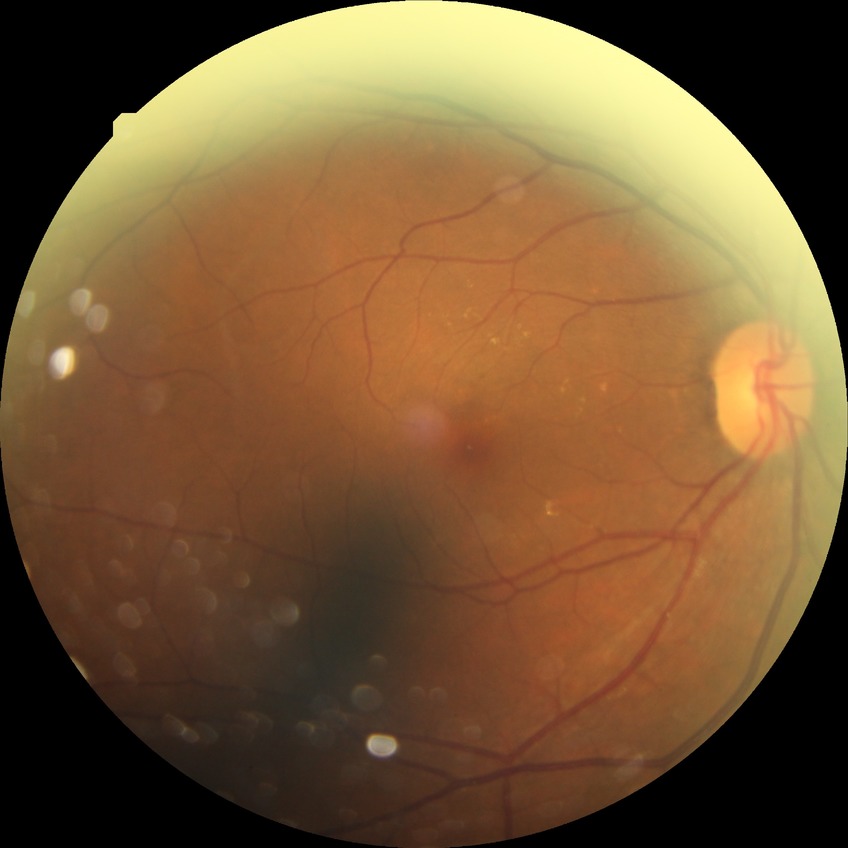 Diabetic retinopathy (DR) is NDR (no diabetic retinopathy).